1932 by 1932 pixels · 45-degree field of view · CFP
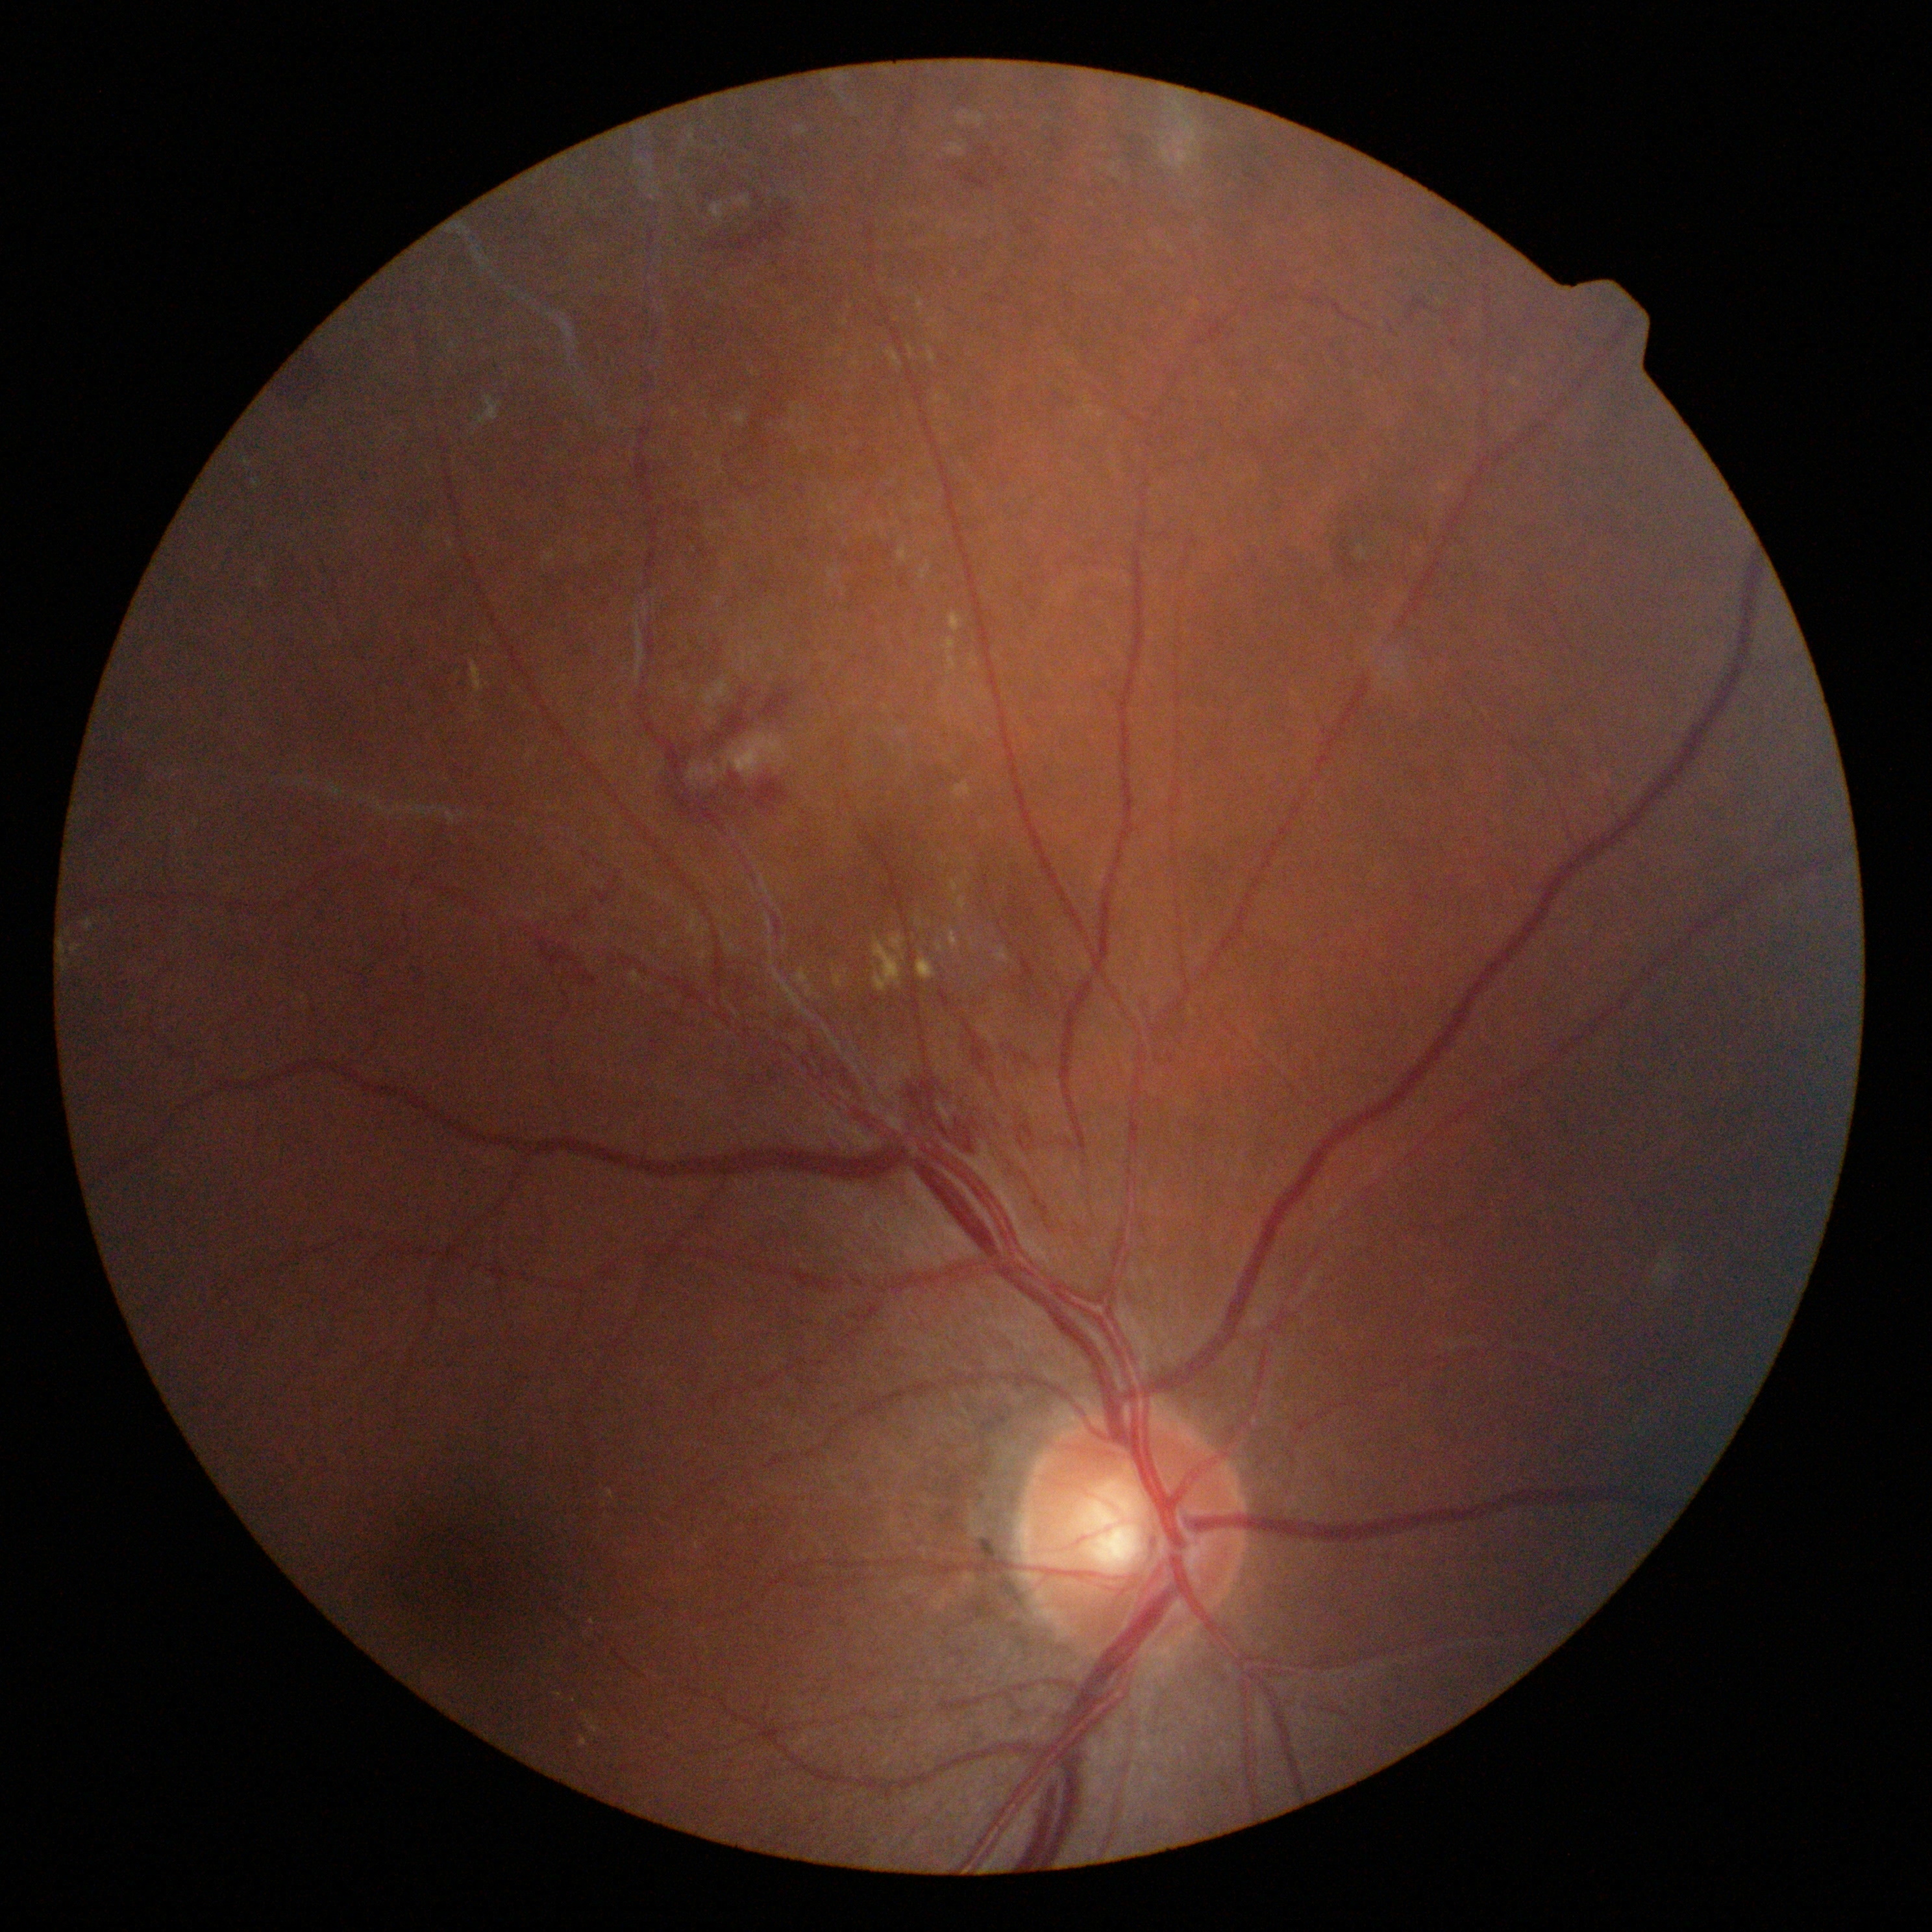

Annotations:
– diabetic retinopathy — 3 — more than 20 intraretinal hemorrhages in each of 4 quadrants, definite venous beading in 2 or more quadrants, or prominent intraretinal microvascular abnormalities in 1 or more quadrants, with no signs of proliferative retinopathy